Diabetic retinopathy graded by the modified Davis classification — 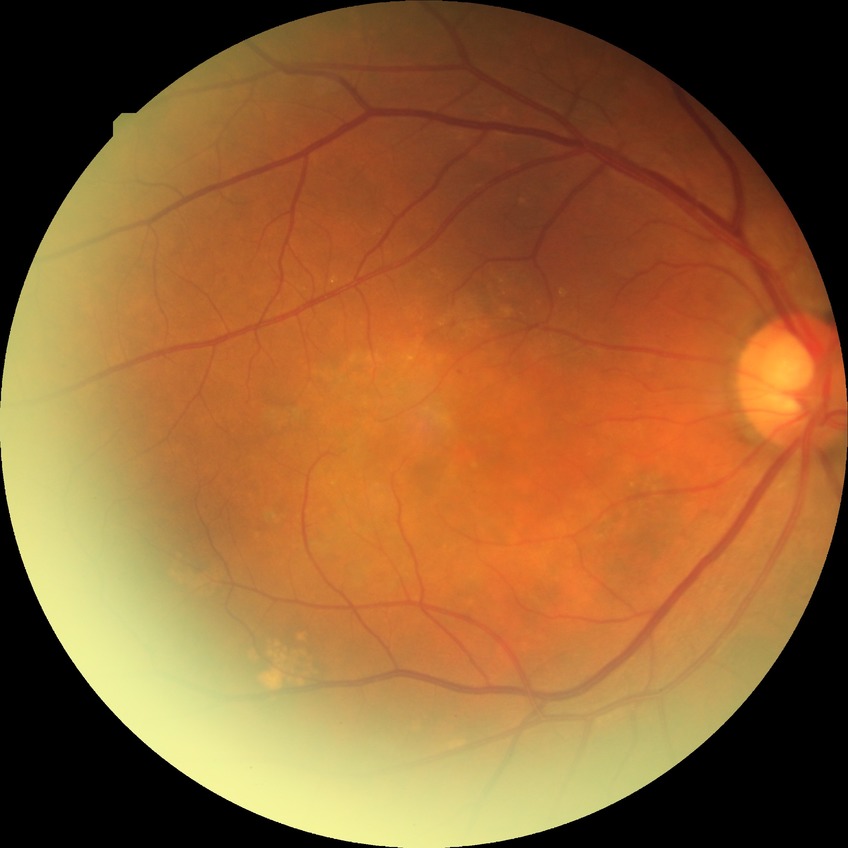
Diabetic retinopathy (DR): SDR (simple diabetic retinopathy).